2089 x 1764 pixels, color fundus image.
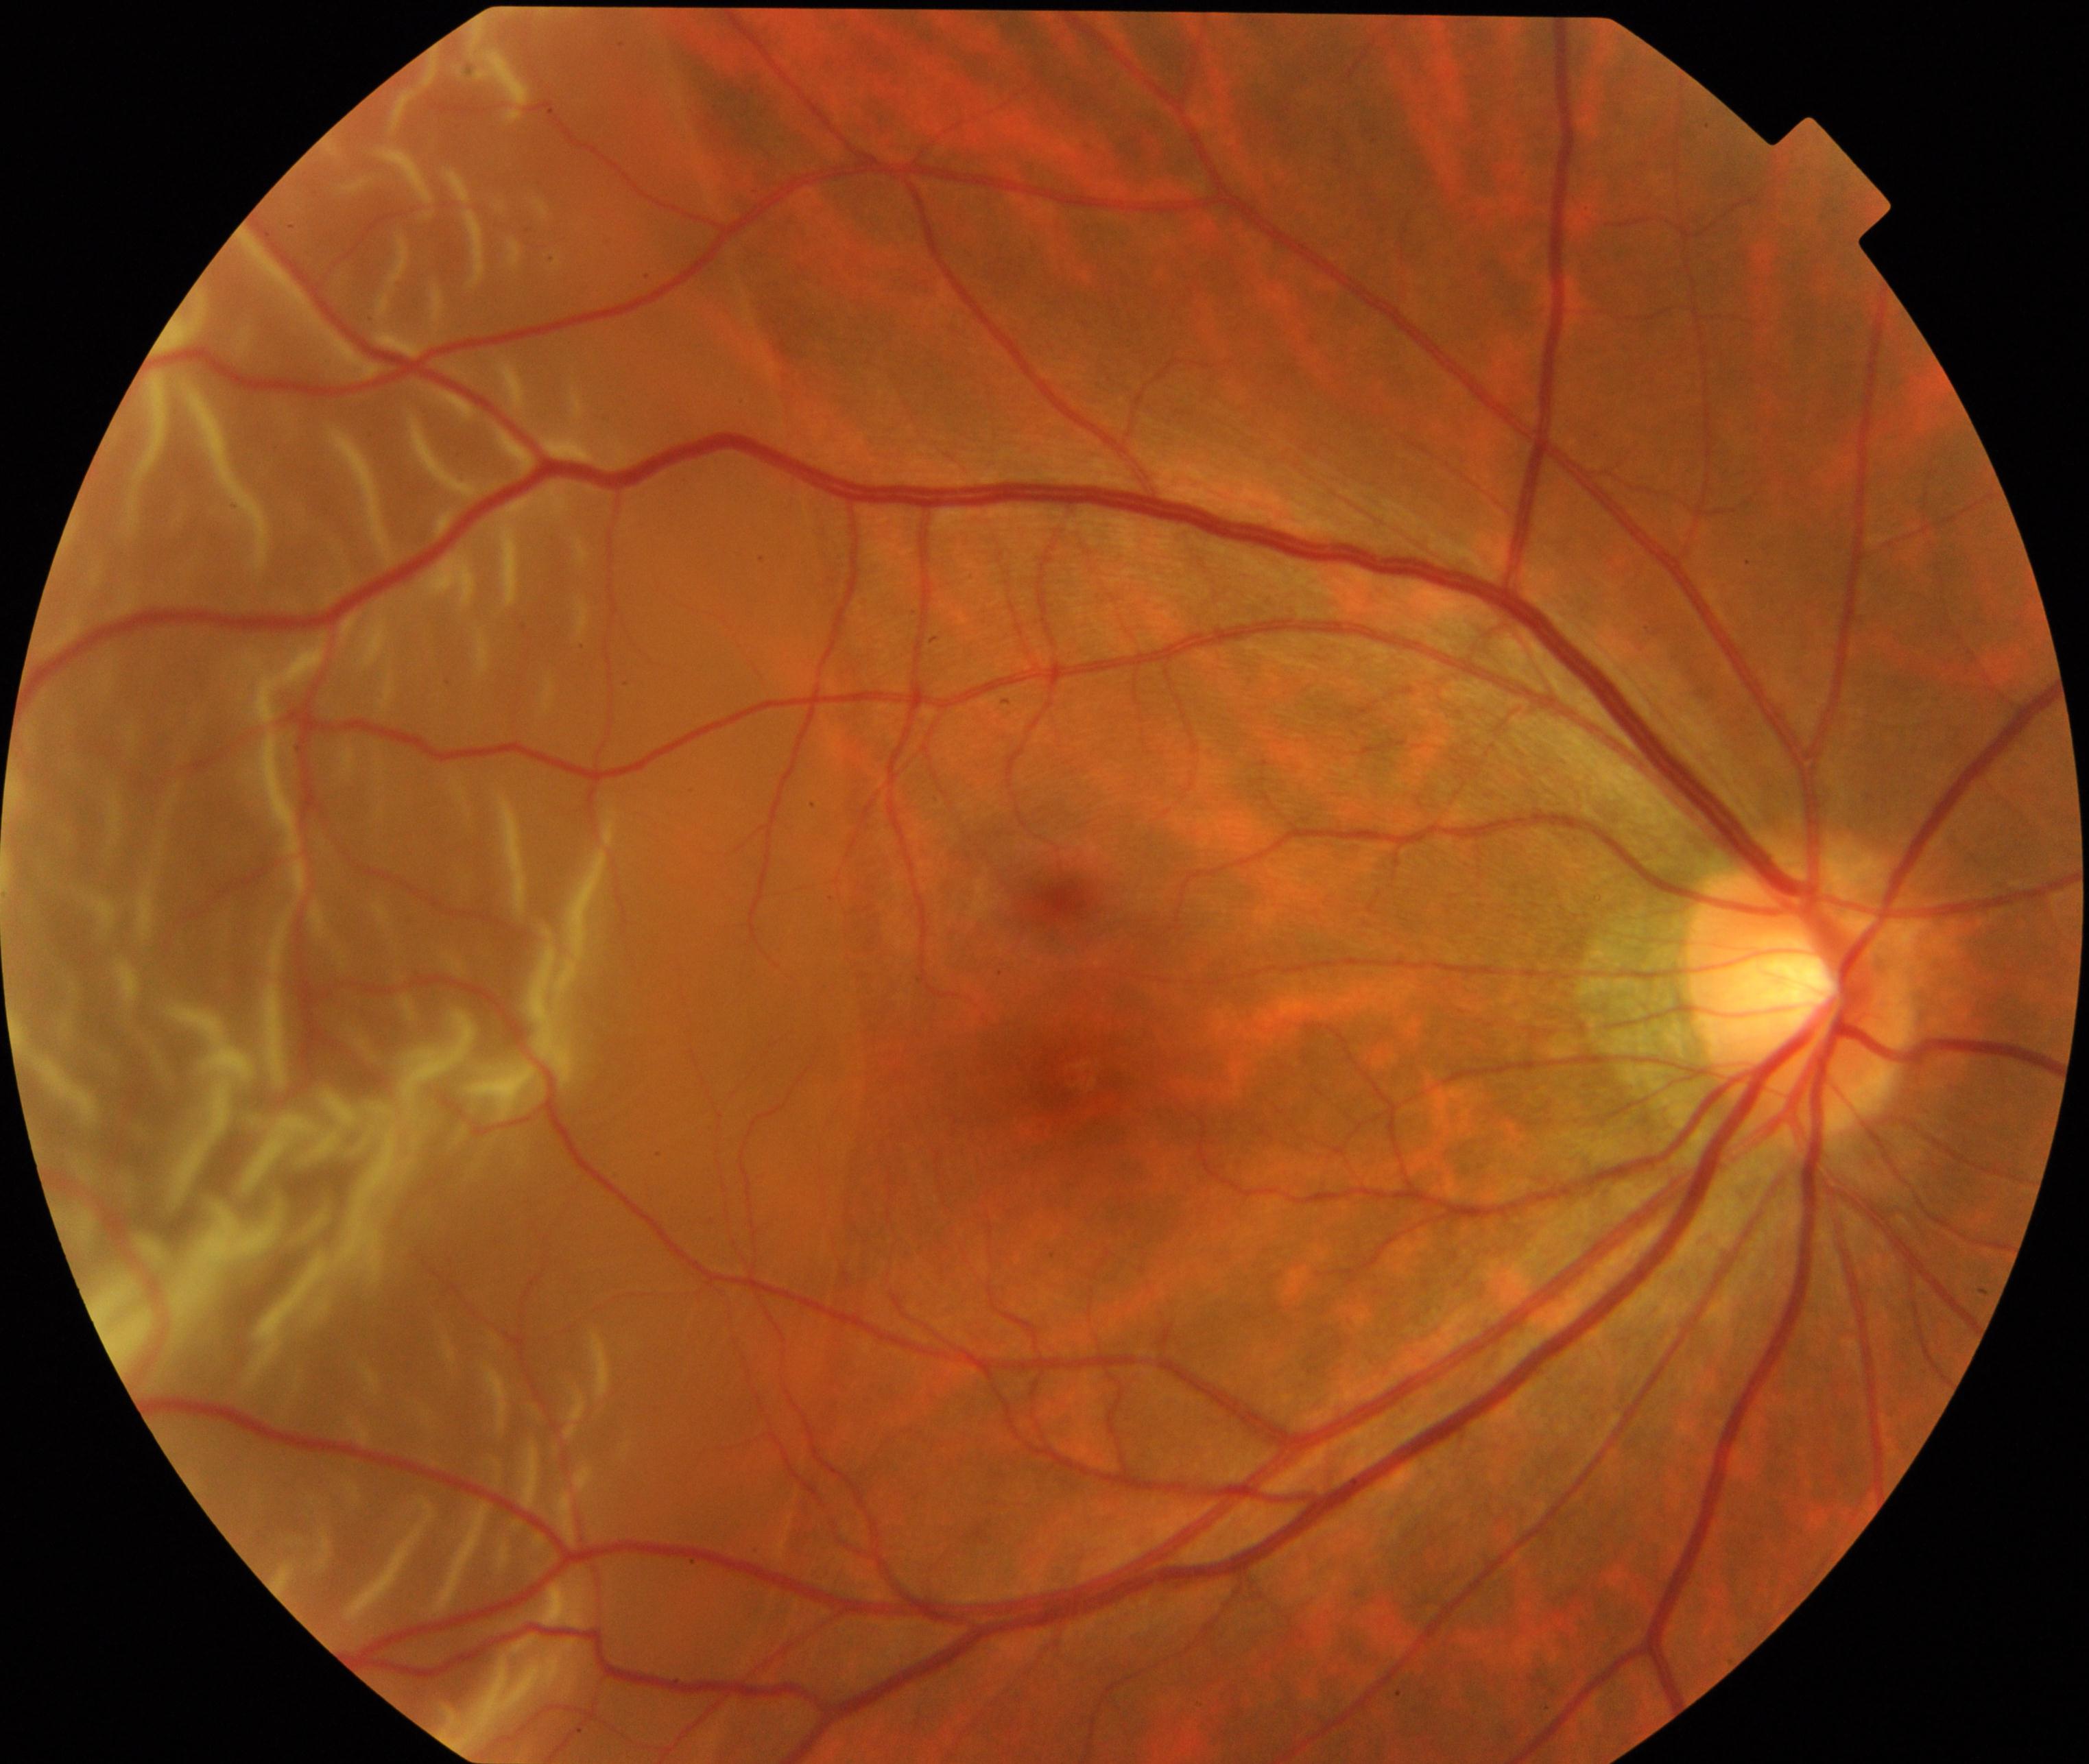 Appearance consistent with rhegmatogenous retinal detachment.